CFP; nonmydriatic.
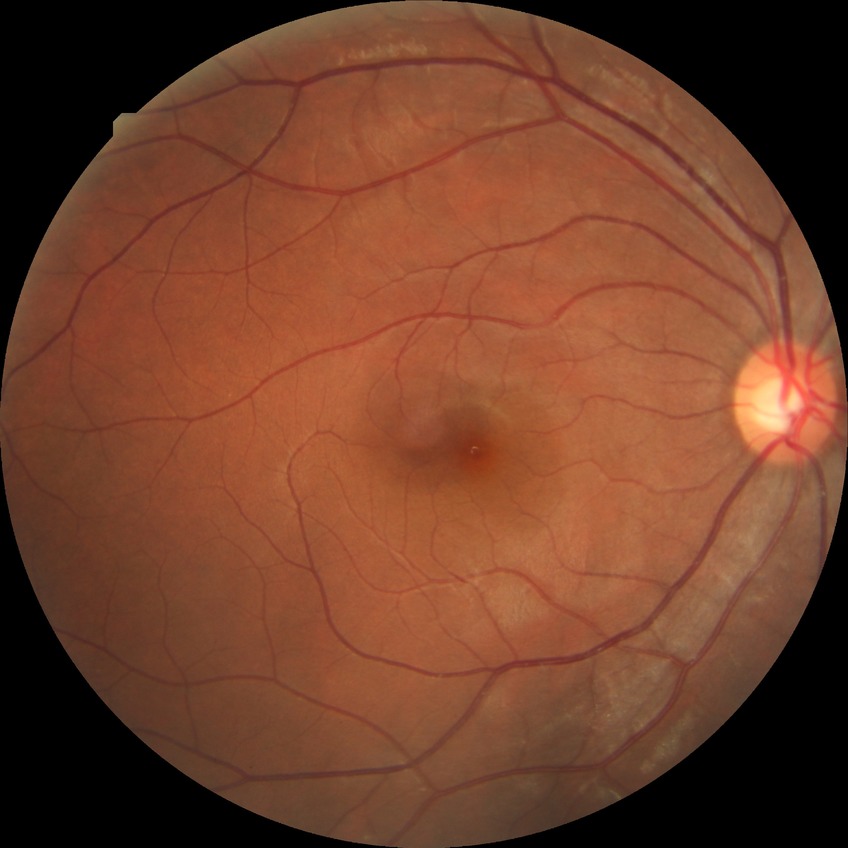

Retinopathy stage: no diabetic retinopathy.